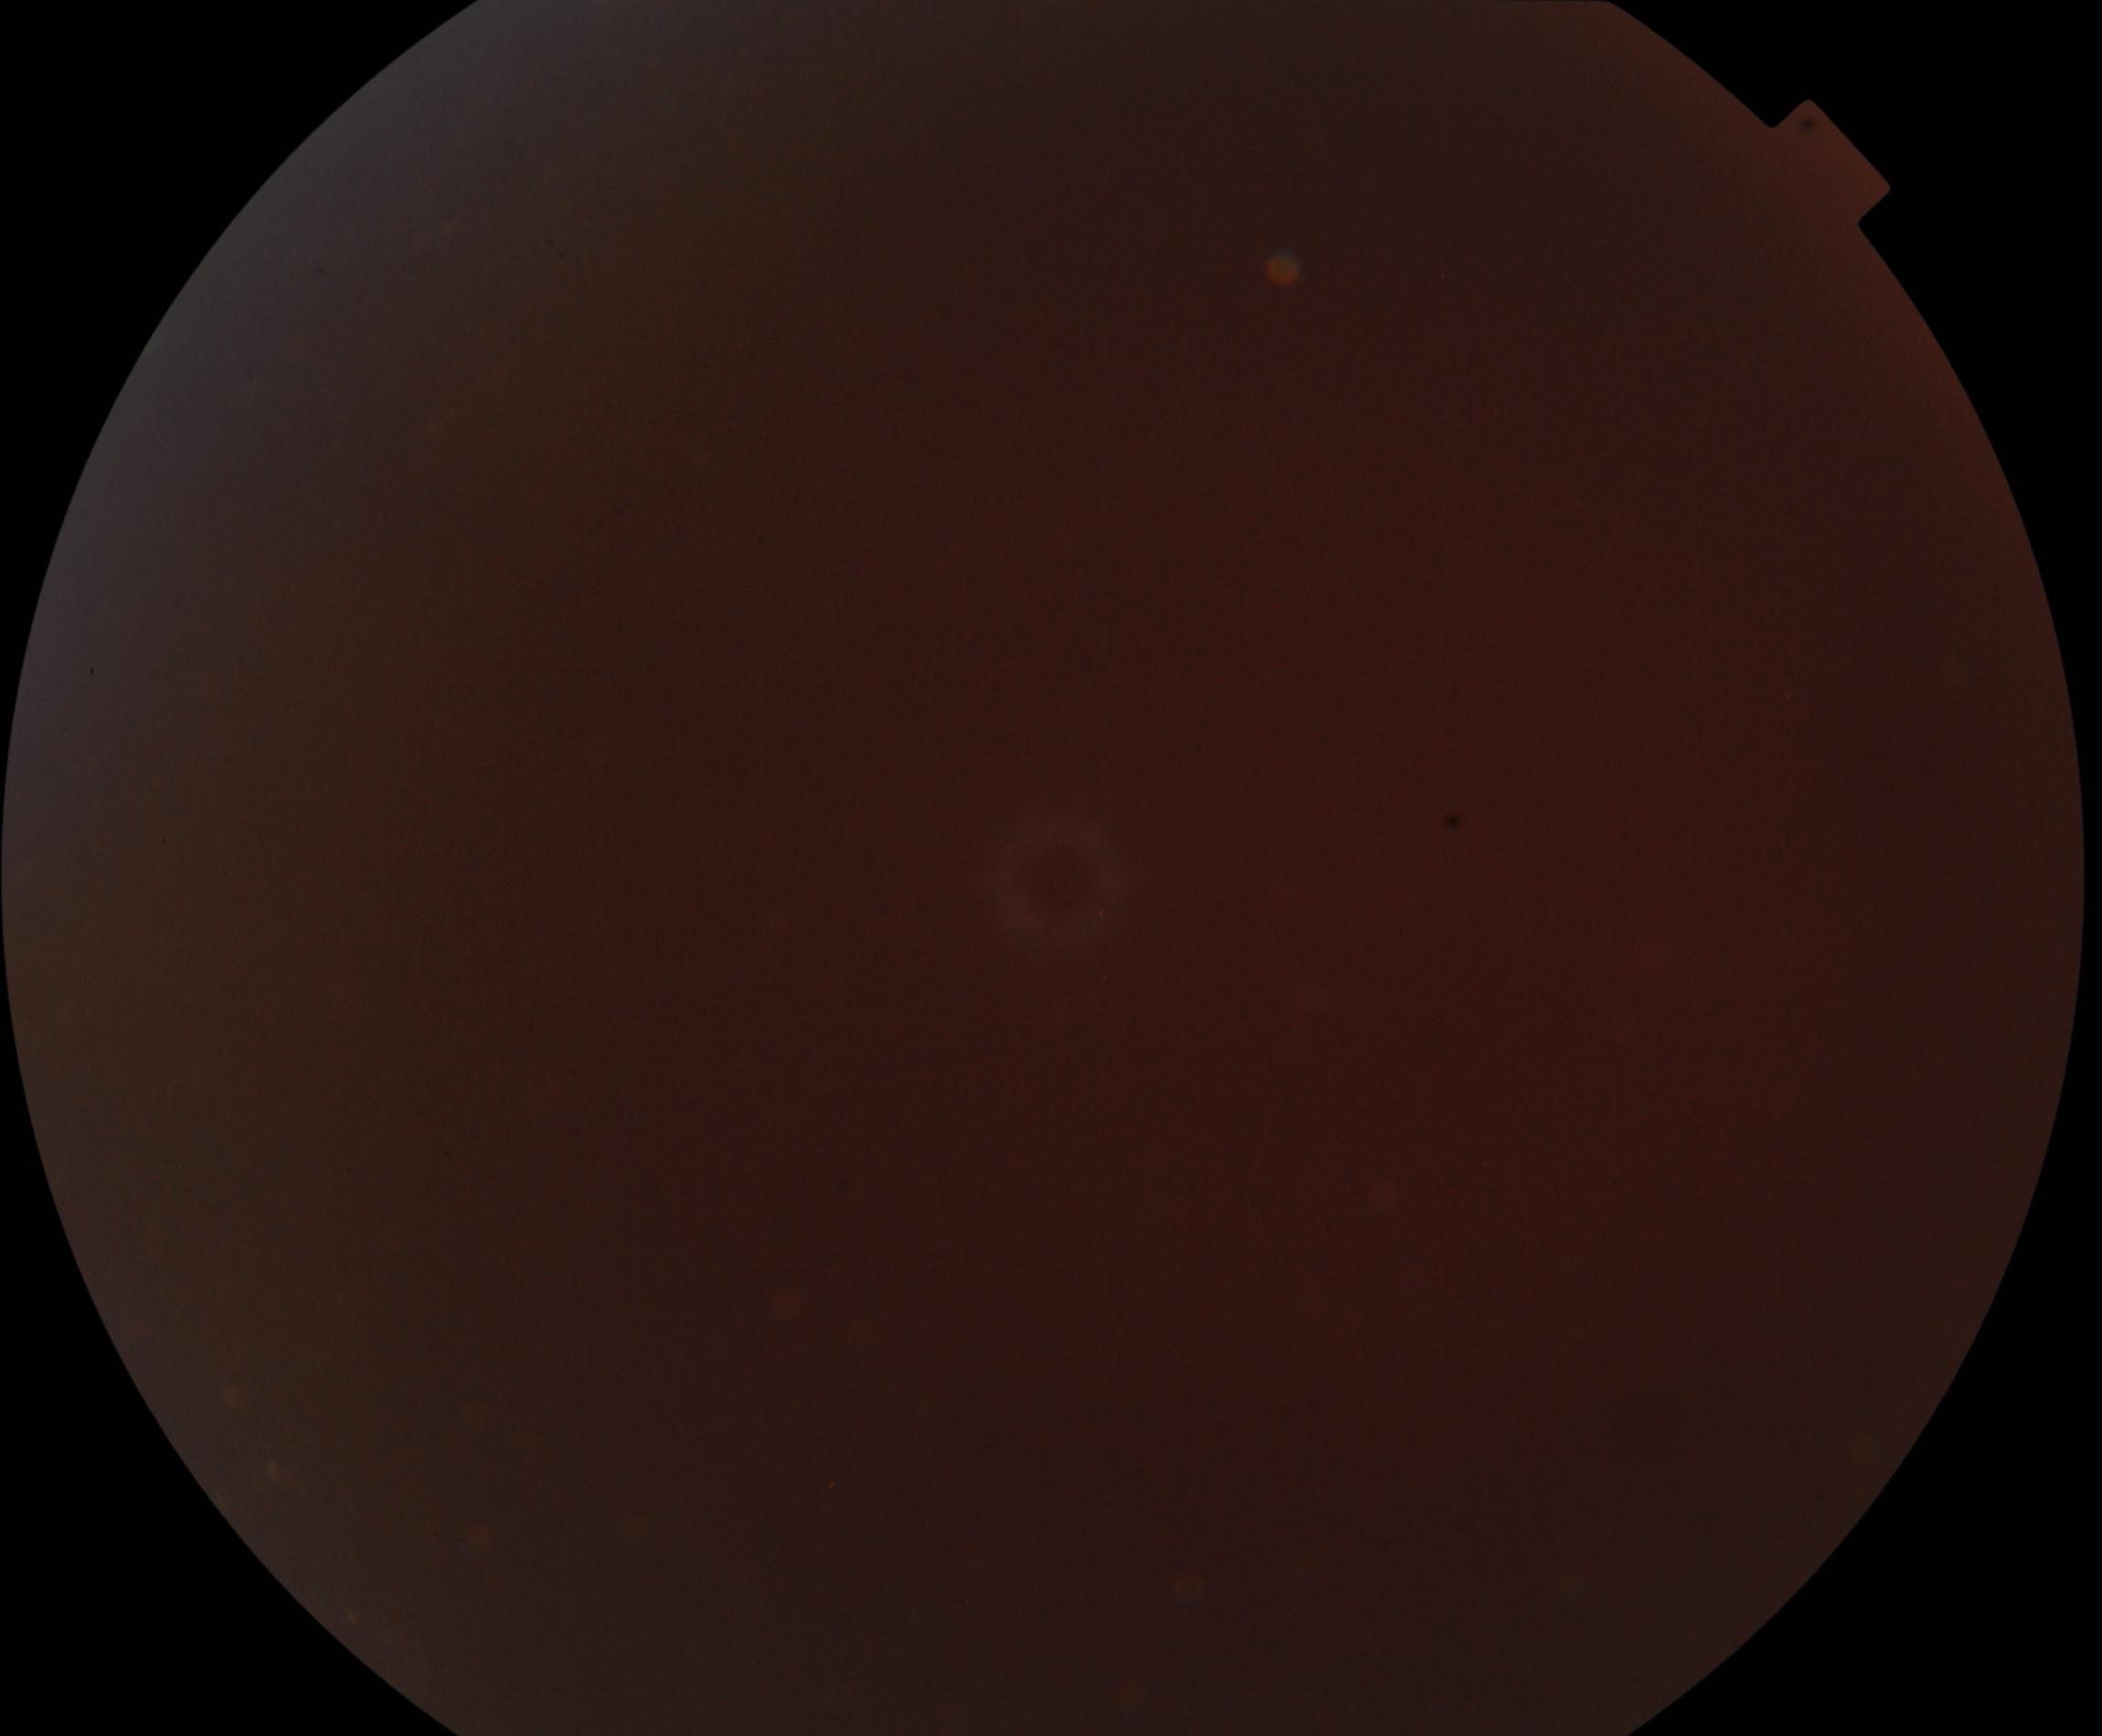 Significantly degraded image quality with obscured retinal detail. Proliferative diabetic retinopathy not identified in the visible portion.